NIDEK AFC-230
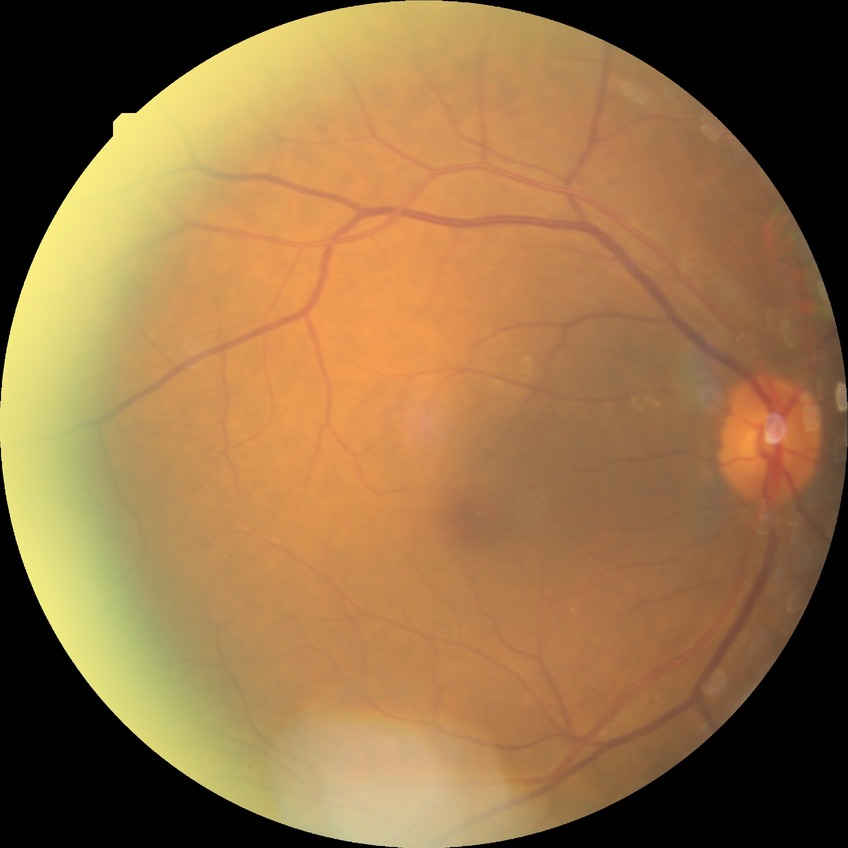 diabetic retinopathy (DR): simple diabetic retinopathy (SDR).